FOV: 45 degrees — 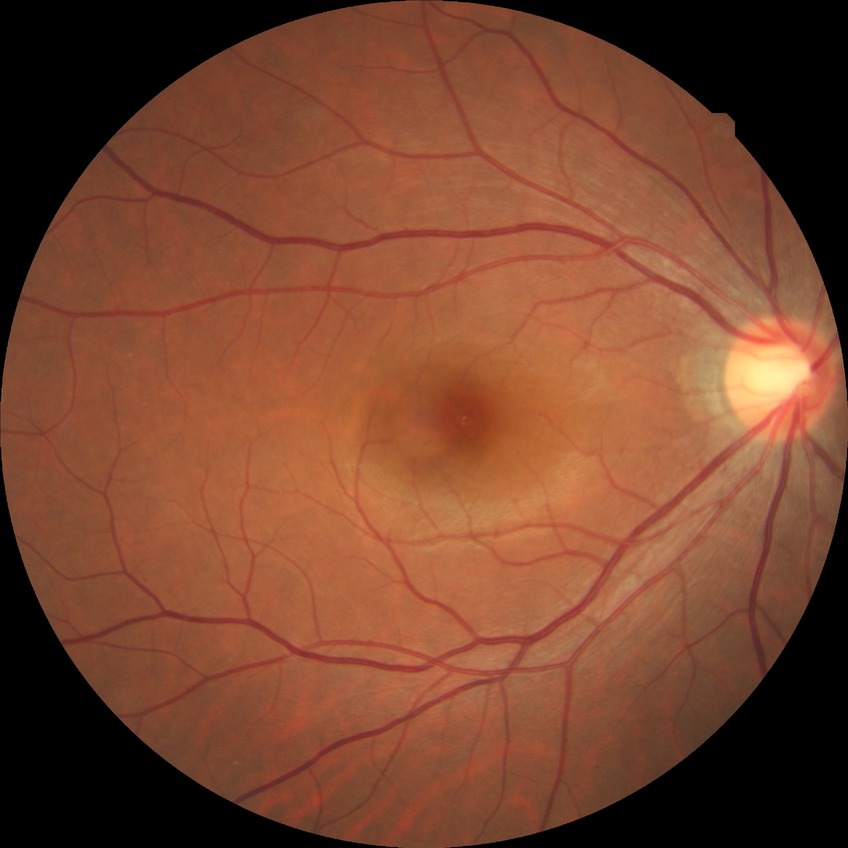 DR stage: NDR.
No DR findings.